50° field of view:
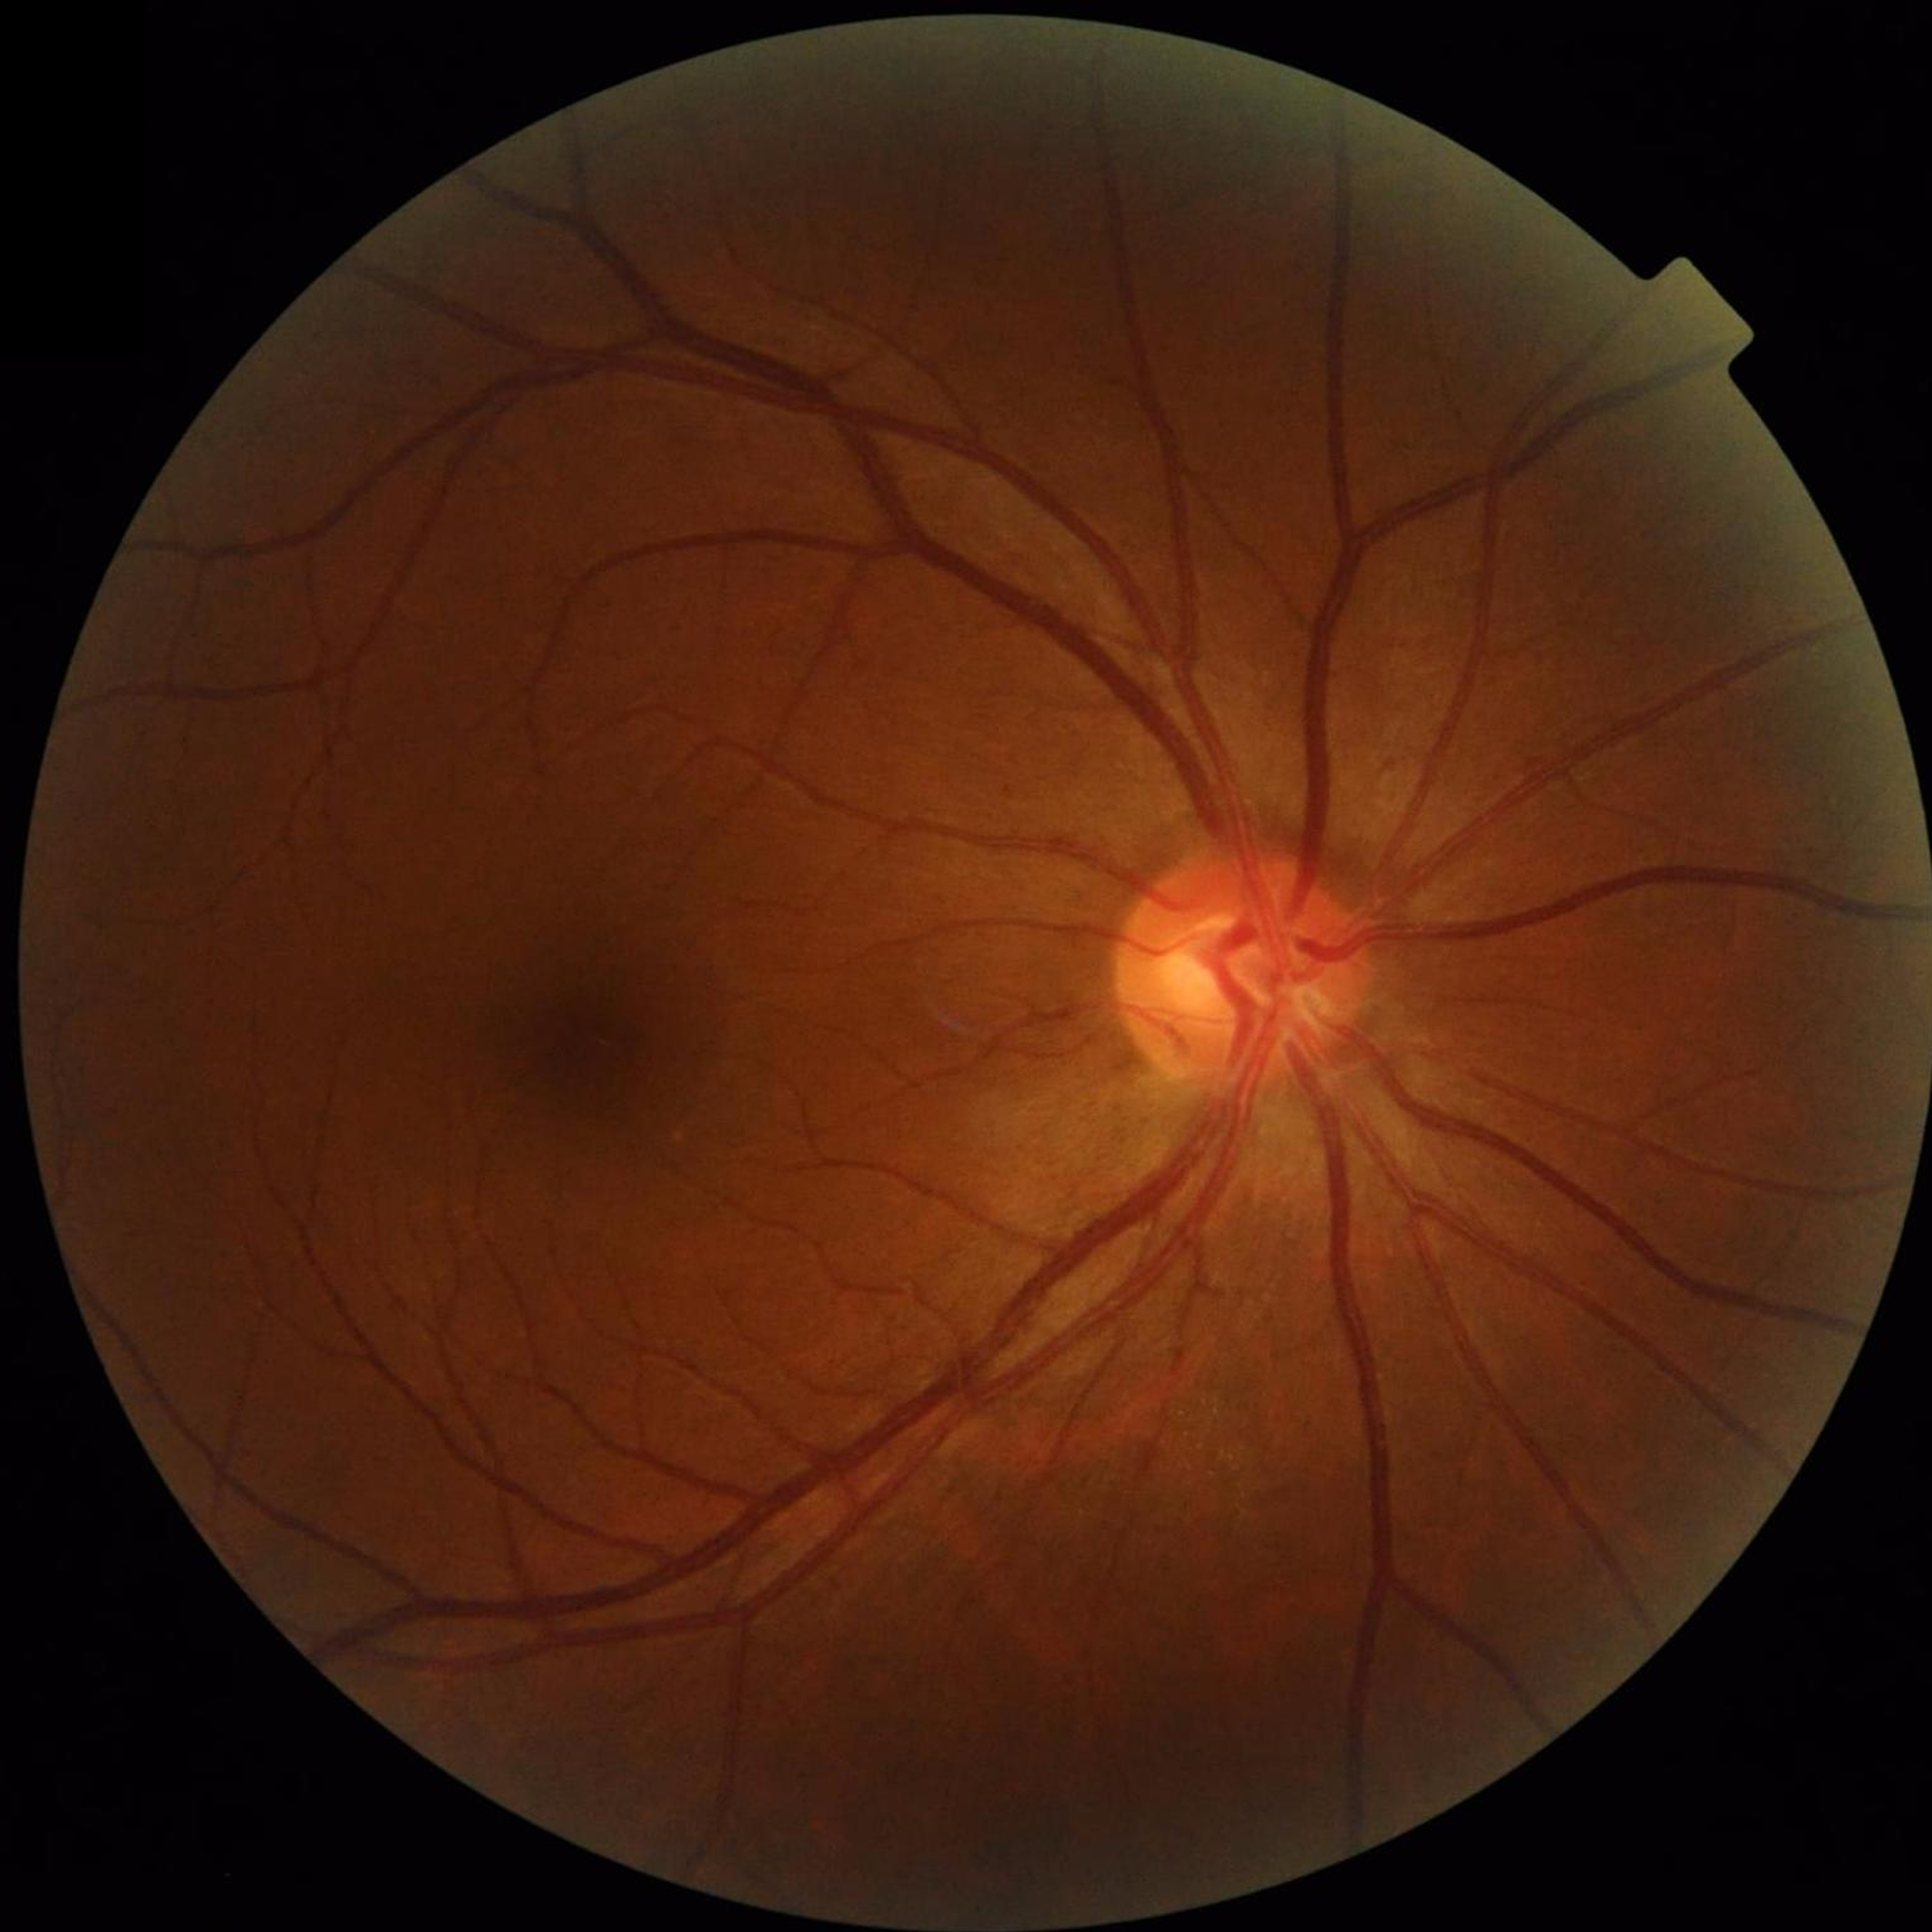

Image quality: no concerns identified. No AMD, DR, or glaucomatous findings.